45-degree field of view — 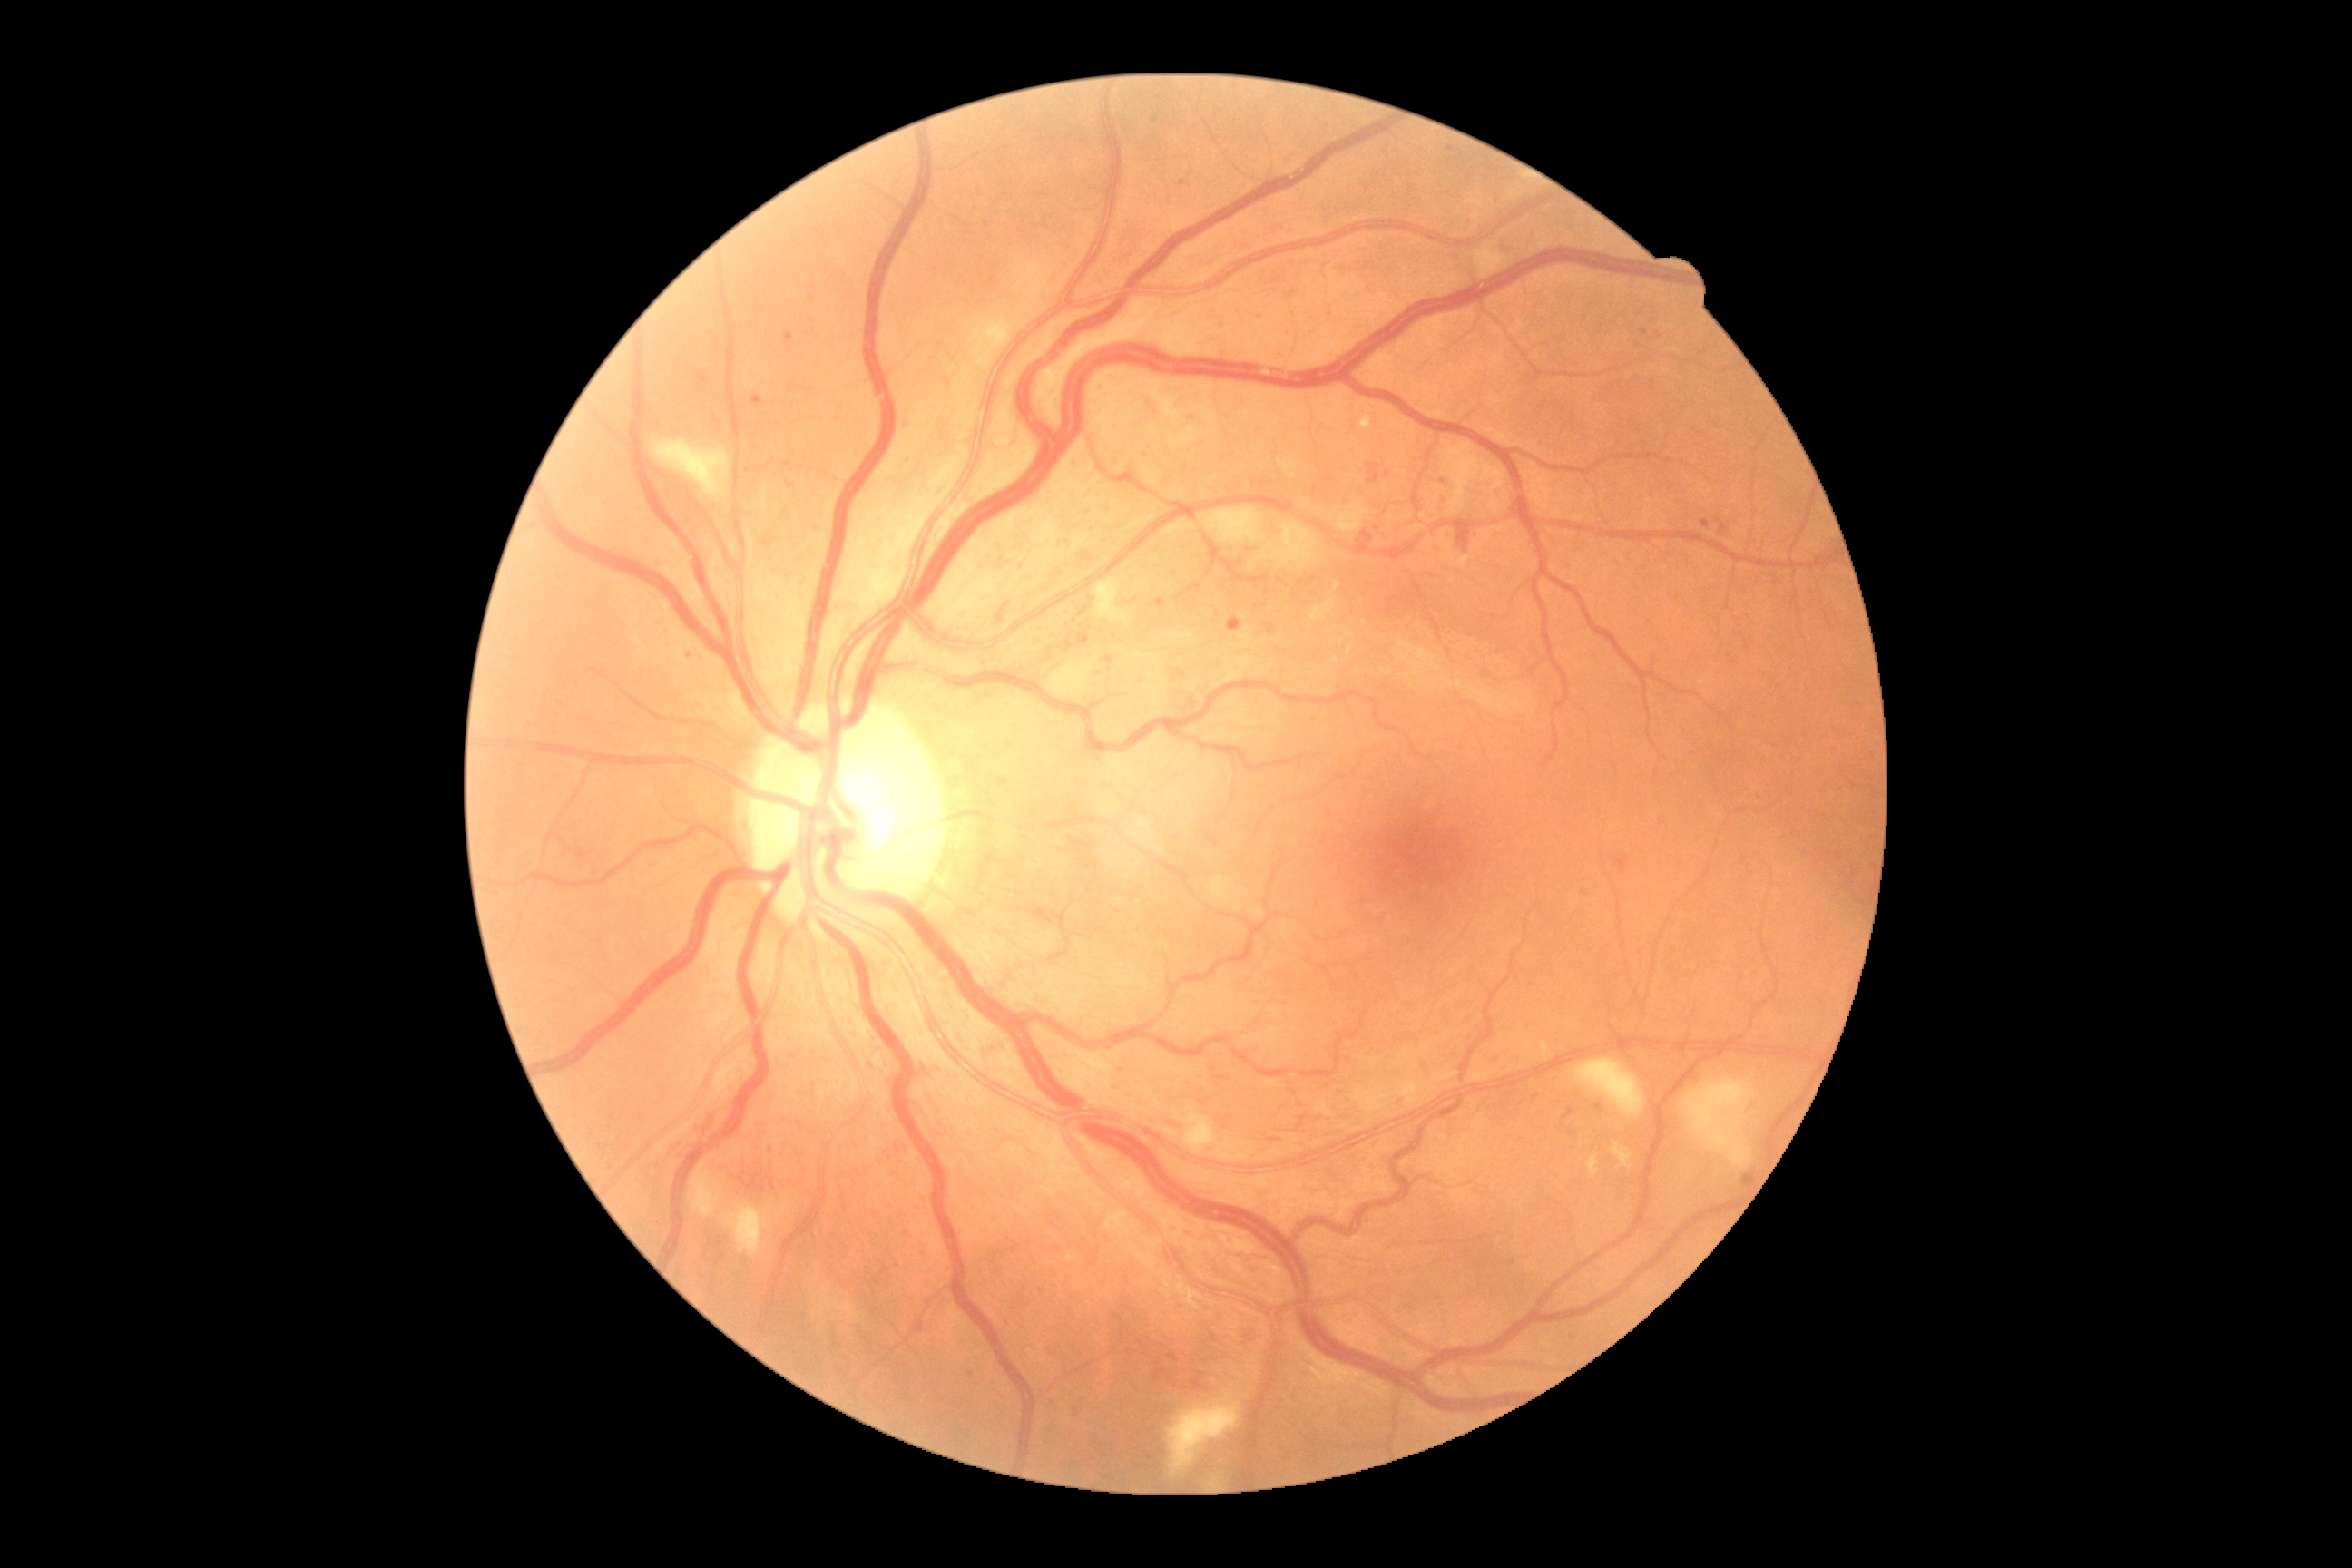 Annotations:
• diabetic retinopathy (DR) — 2/4